1240 by 1240 pixels. Phoenix ICON, 100° FOV. Pediatric retinal photograph (wide-field):
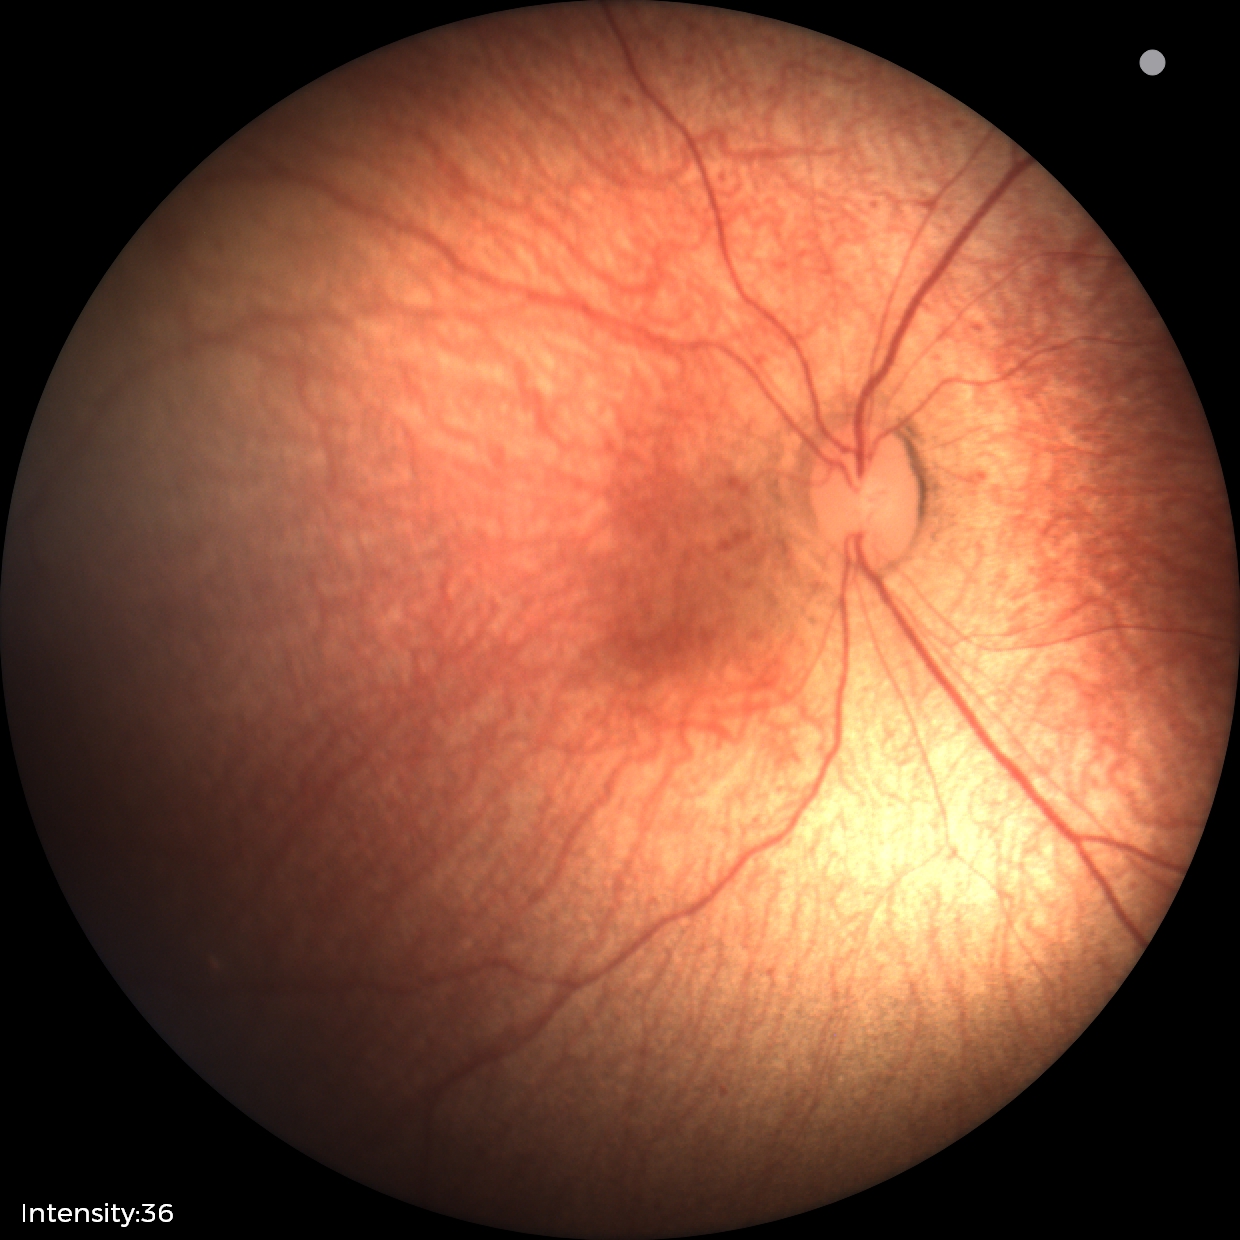 Finding = normal